Wide-field fundus photograph from neonatal ROP screening. Captured with the Clarity RetCam 3 (130° field of view). 640x480: 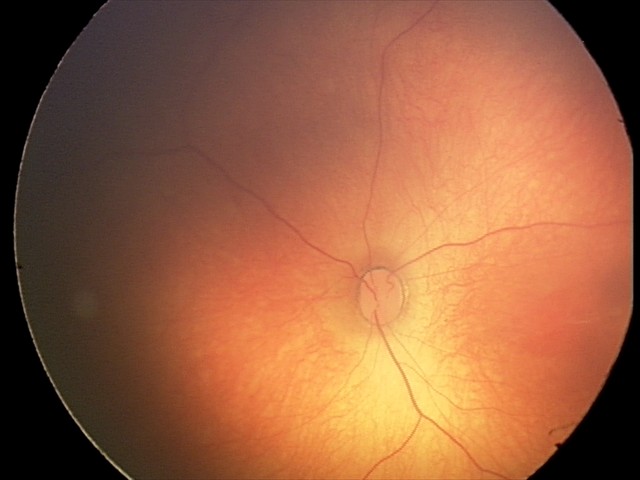

Physiological retinal appearance for postconceptual age.